Fundus photo.
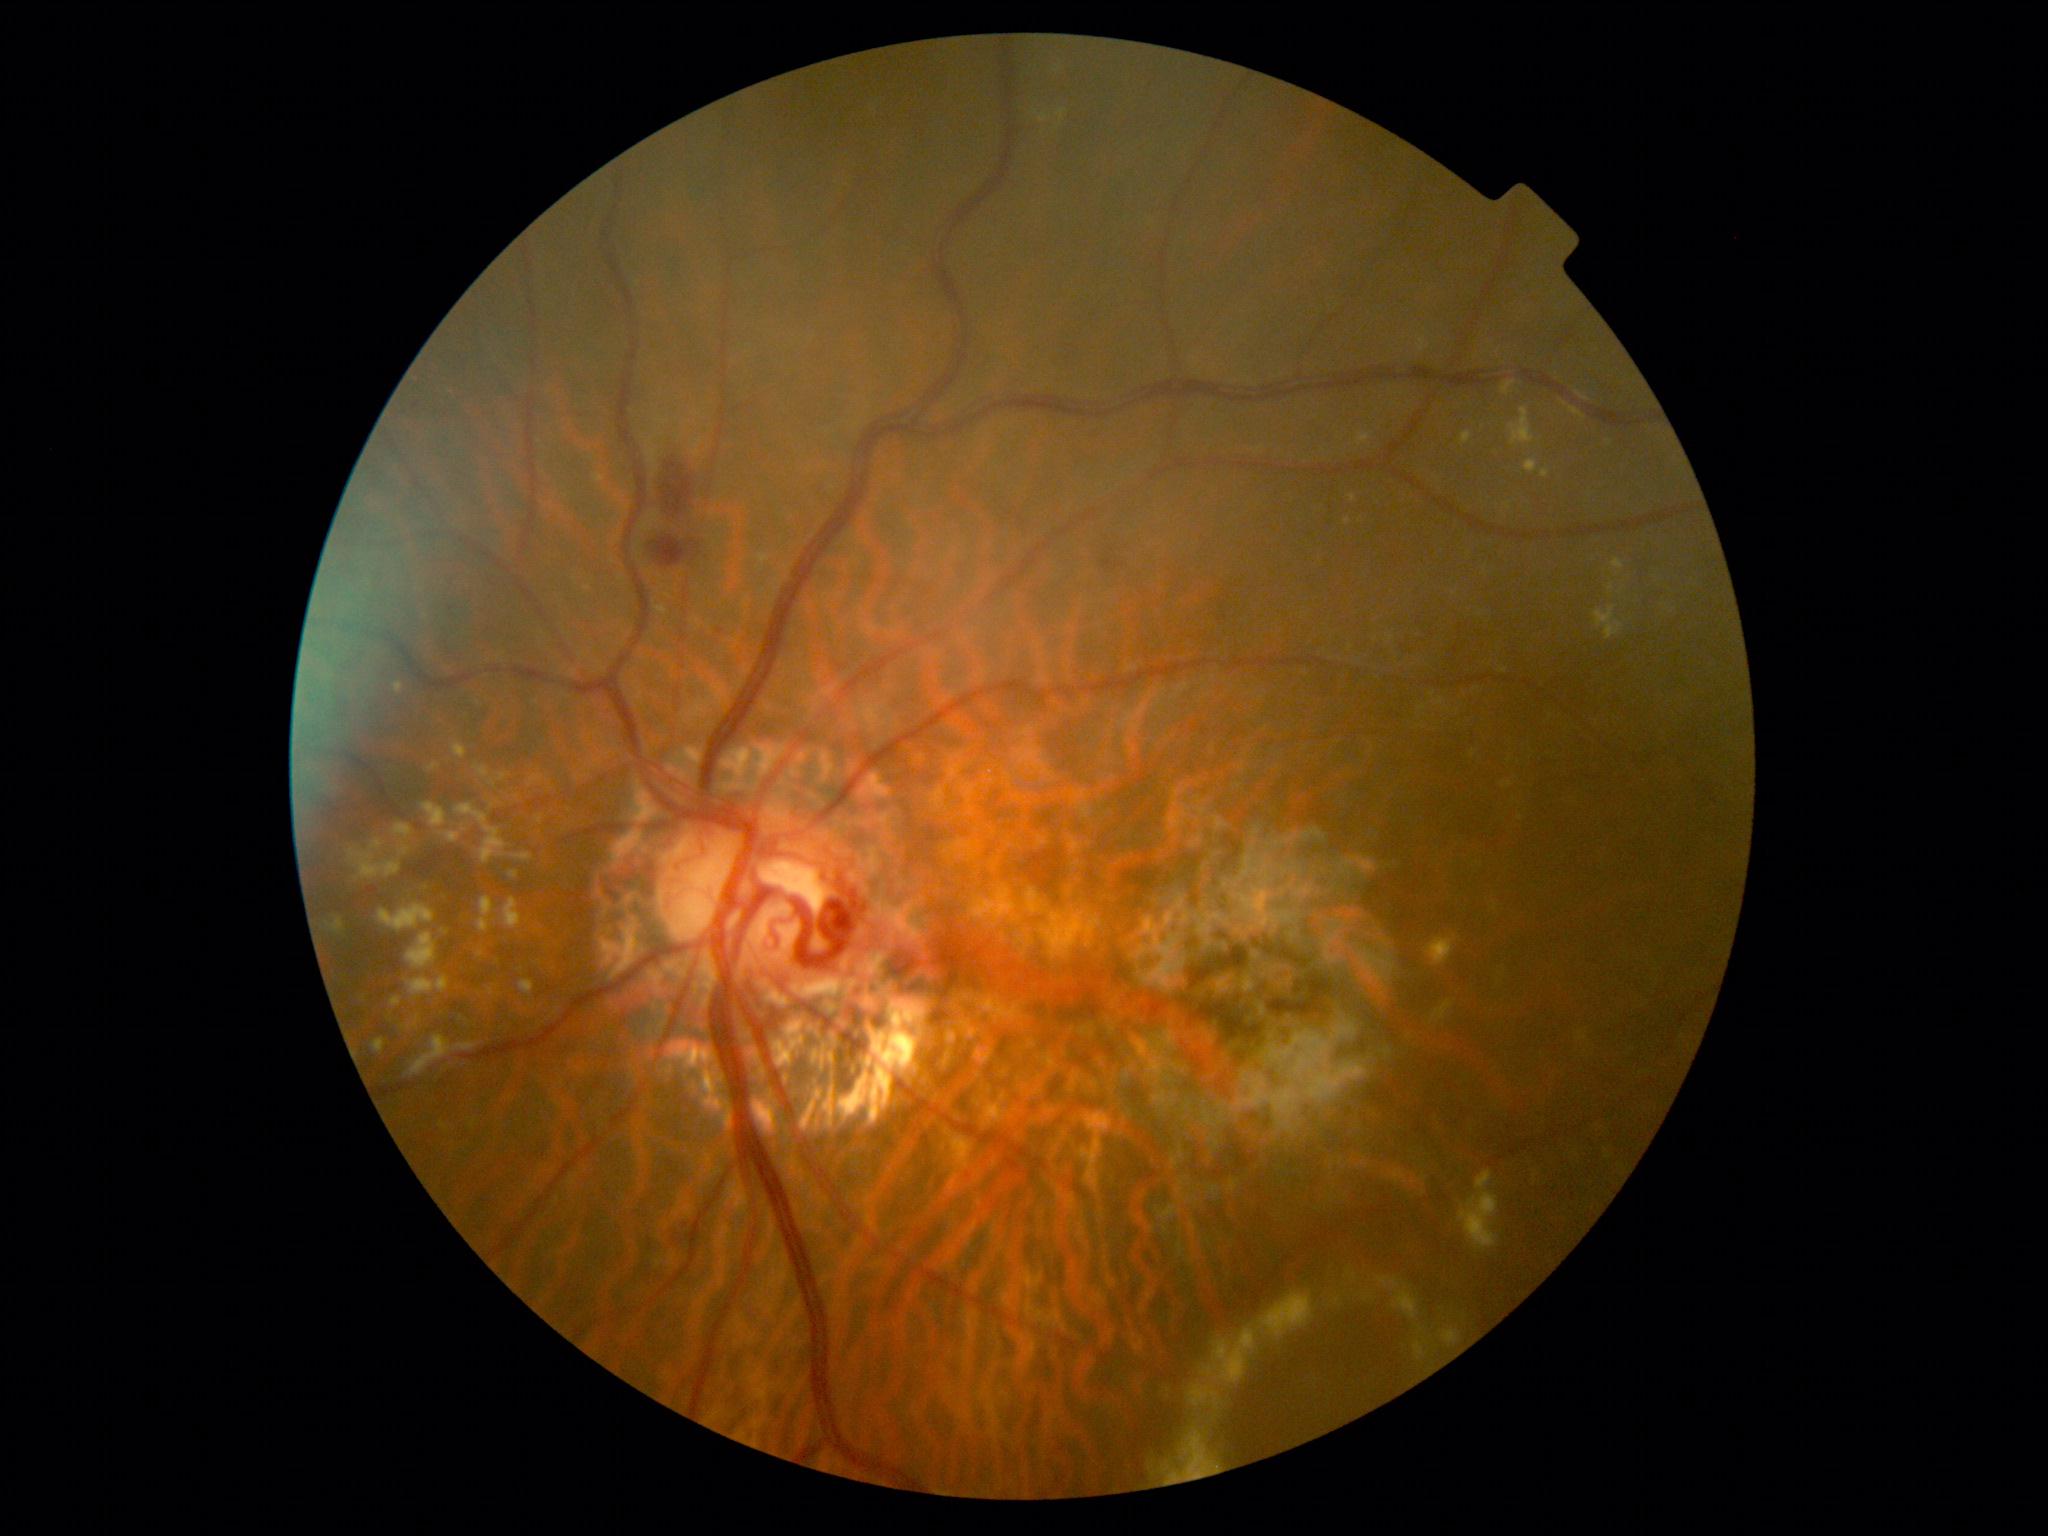 DR grade is moderate non-proliferative diabetic retinopathy (2).